Graded on the modified Davis scale:
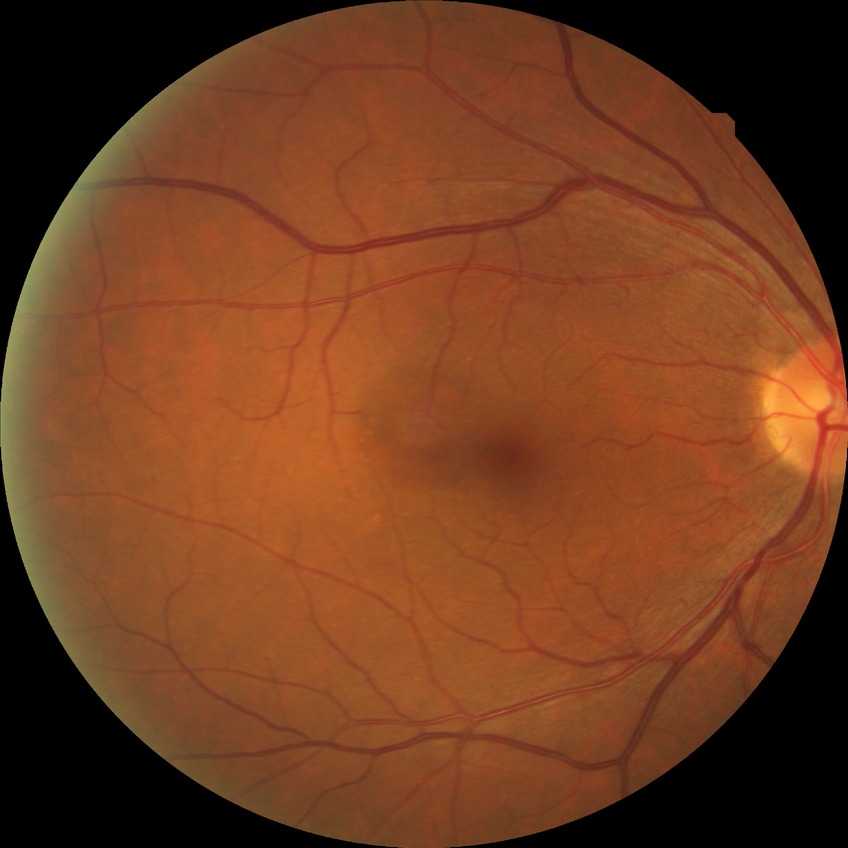

Diabetic retinopathy (DR): NDR (no diabetic retinopathy).